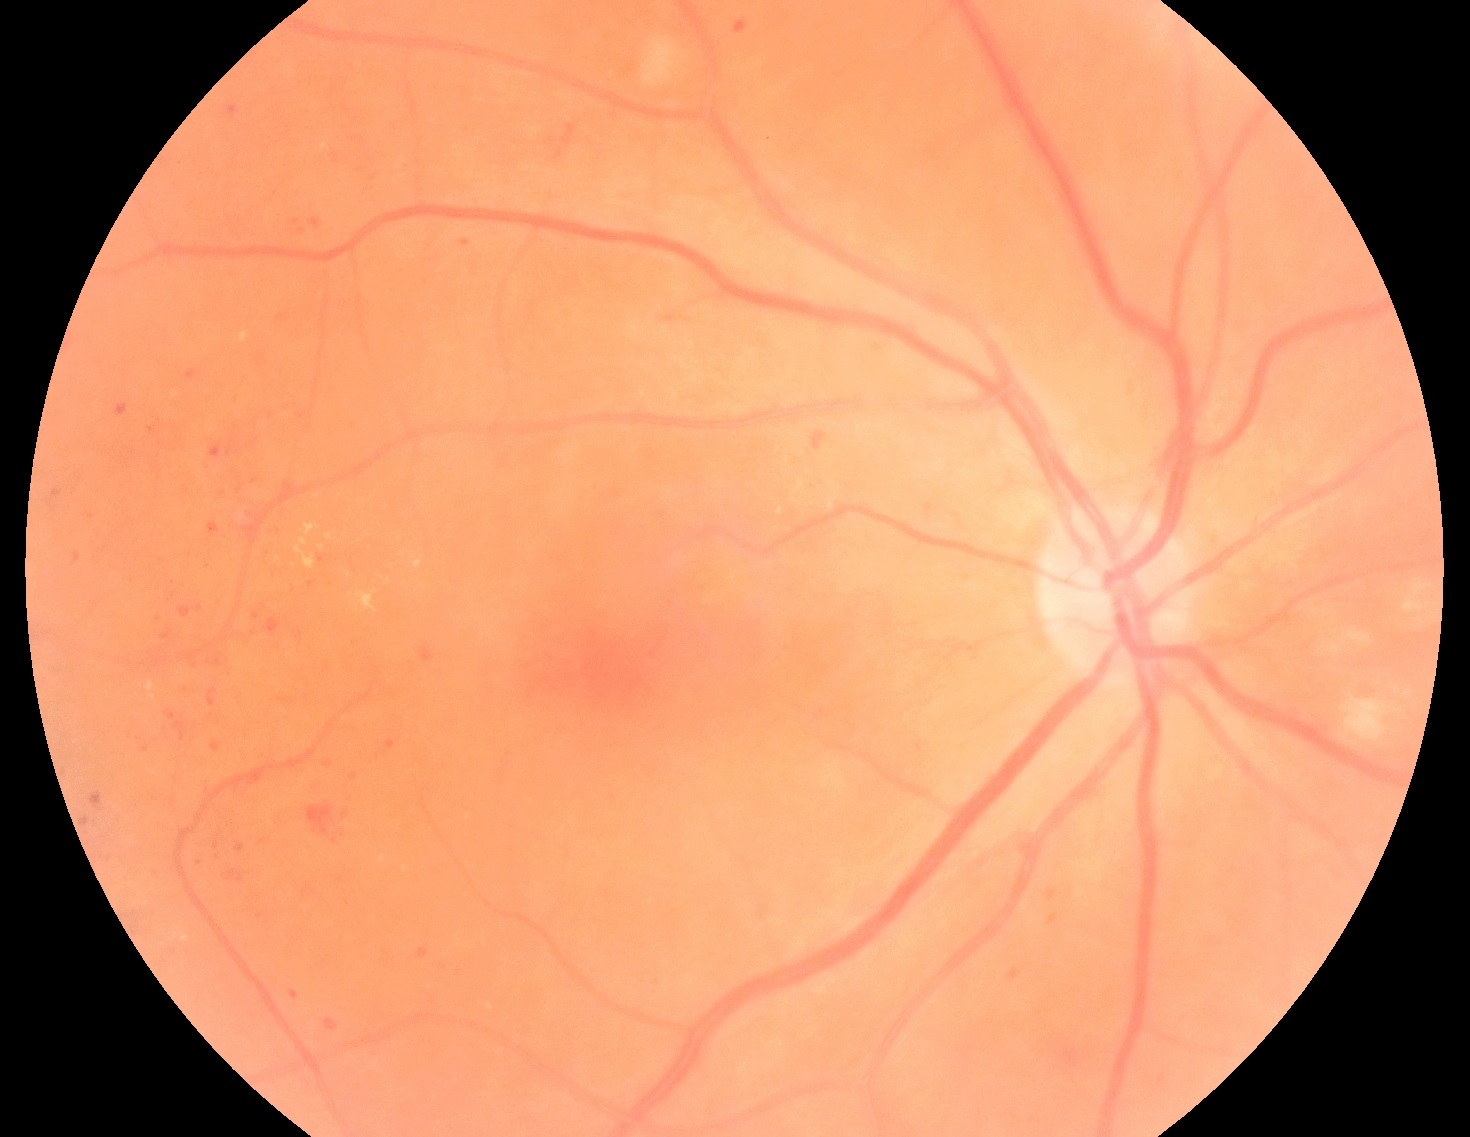

Retinopathy is 2/4.